45° field of view. Color fundus photograph.
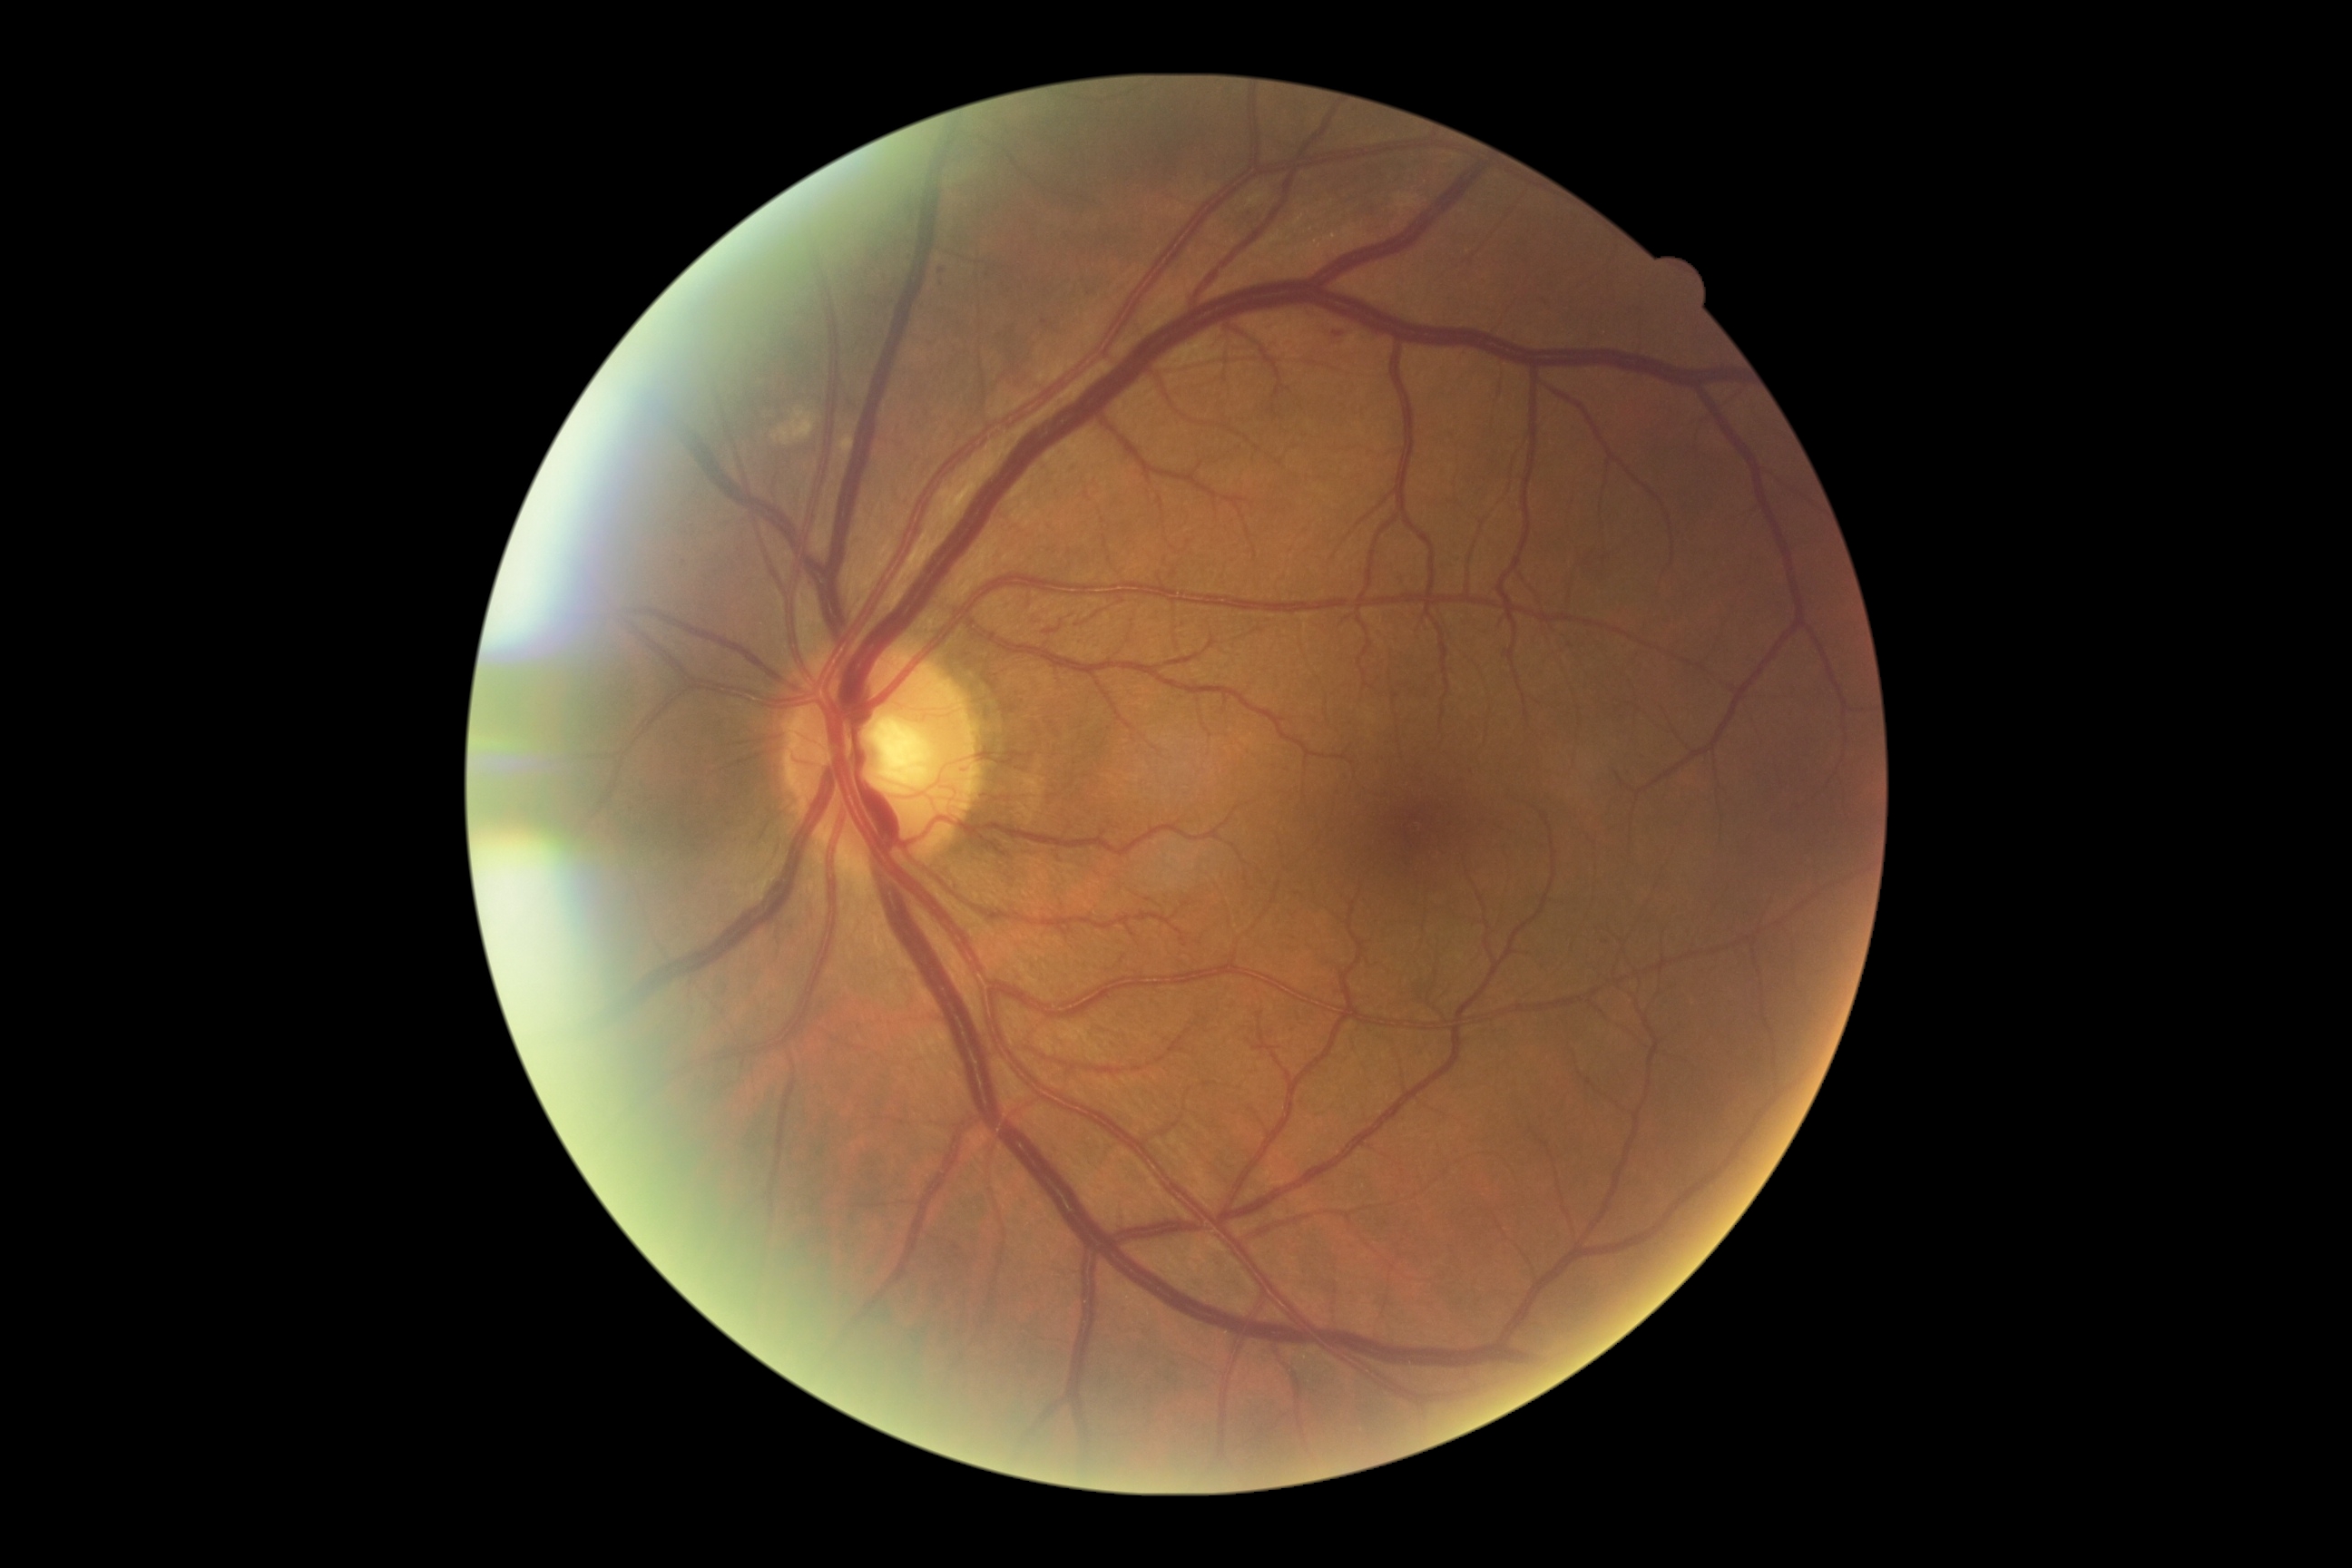

DR class: non-proliferative diabetic retinopathy. Diabetic retinopathy (DR) is grade 2 (moderate NPDR).